FOV: 45 degrees.
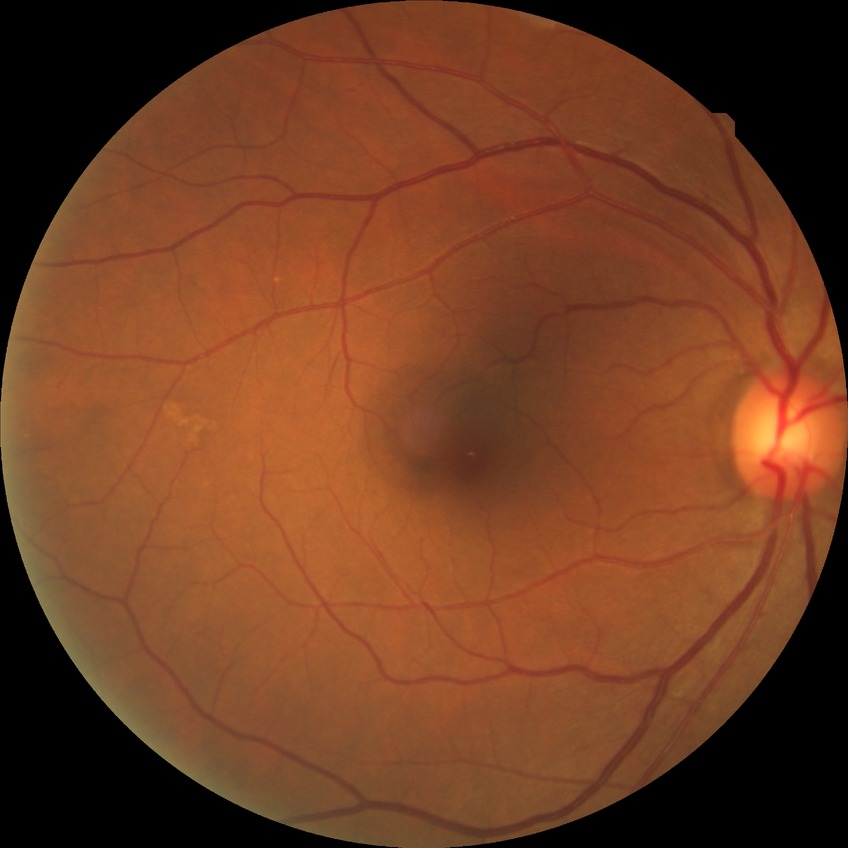
diabetic retinopathy (DR)=no diabetic retinopathy (NDR).